45-degree field of view. 848 x 848 pixels:
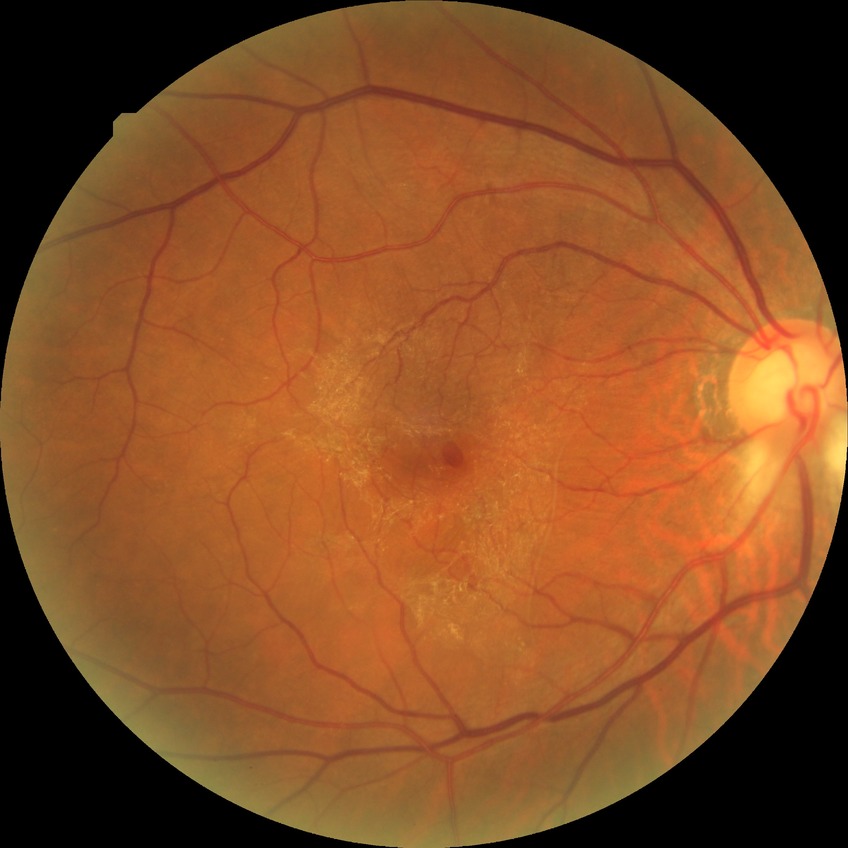
Retinopathy grade is no diabetic retinopathy.